2089 by 1764 pixels:
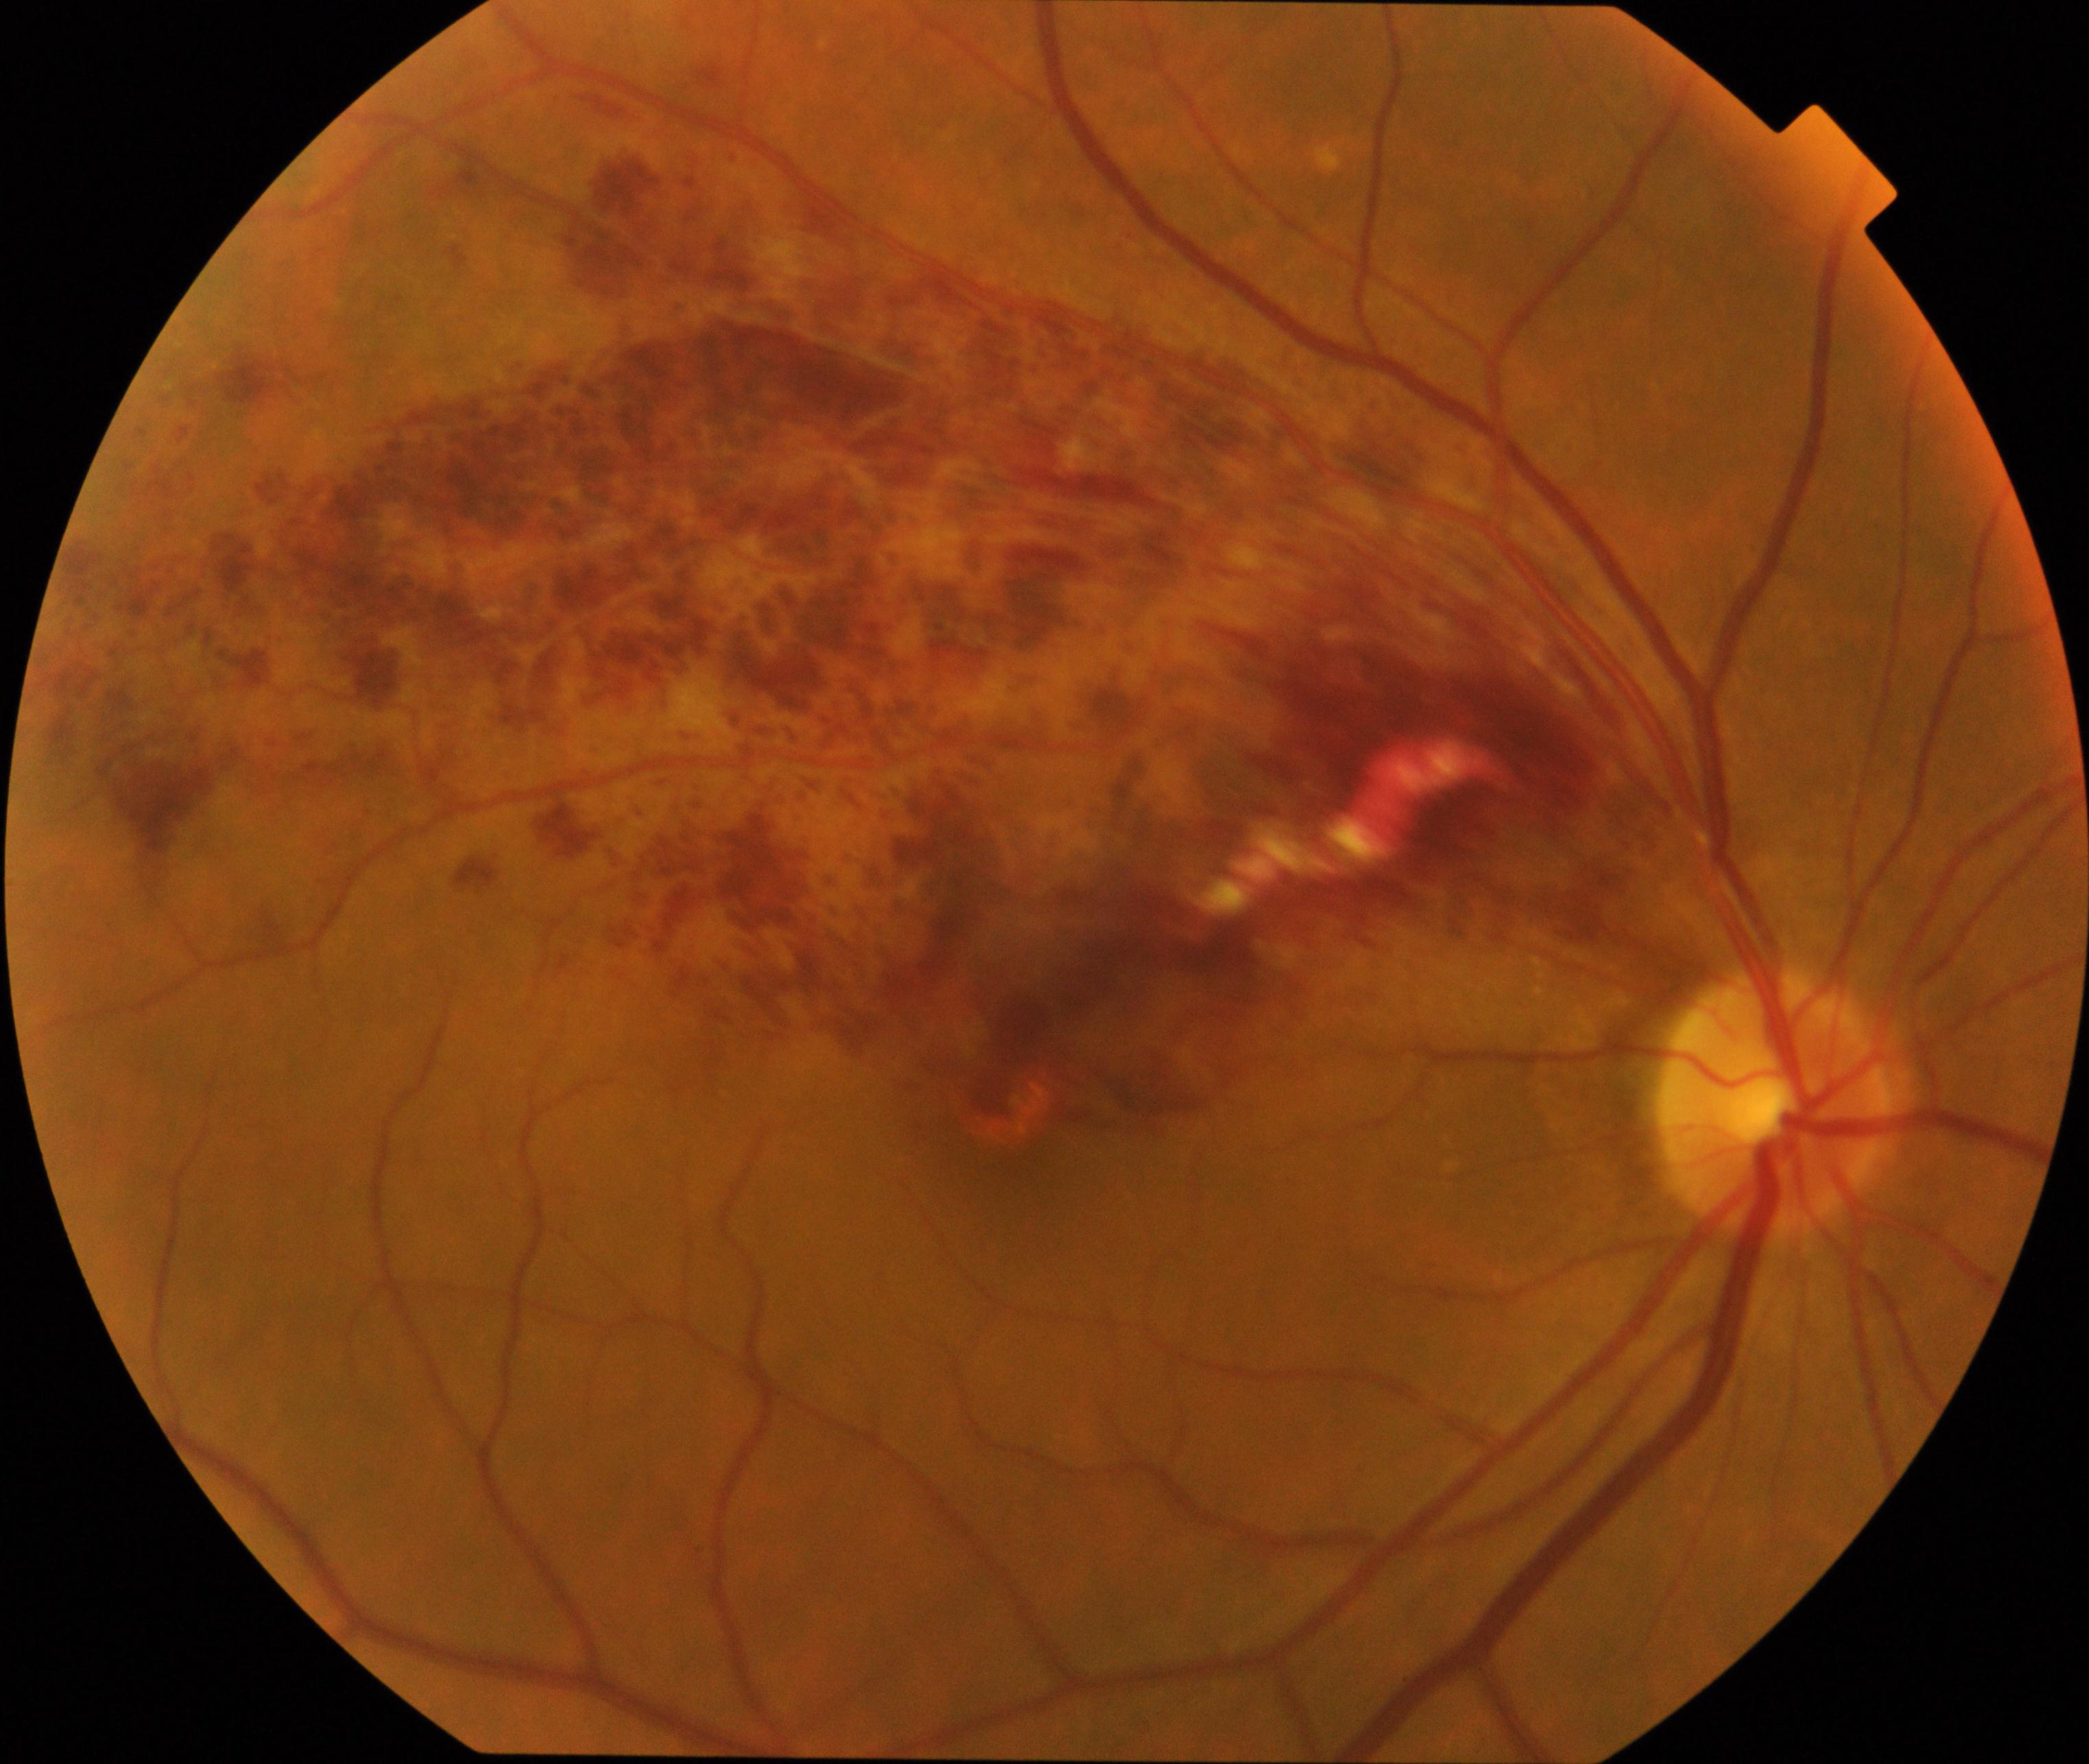

Primary finding: branch retinal vein occlusion.